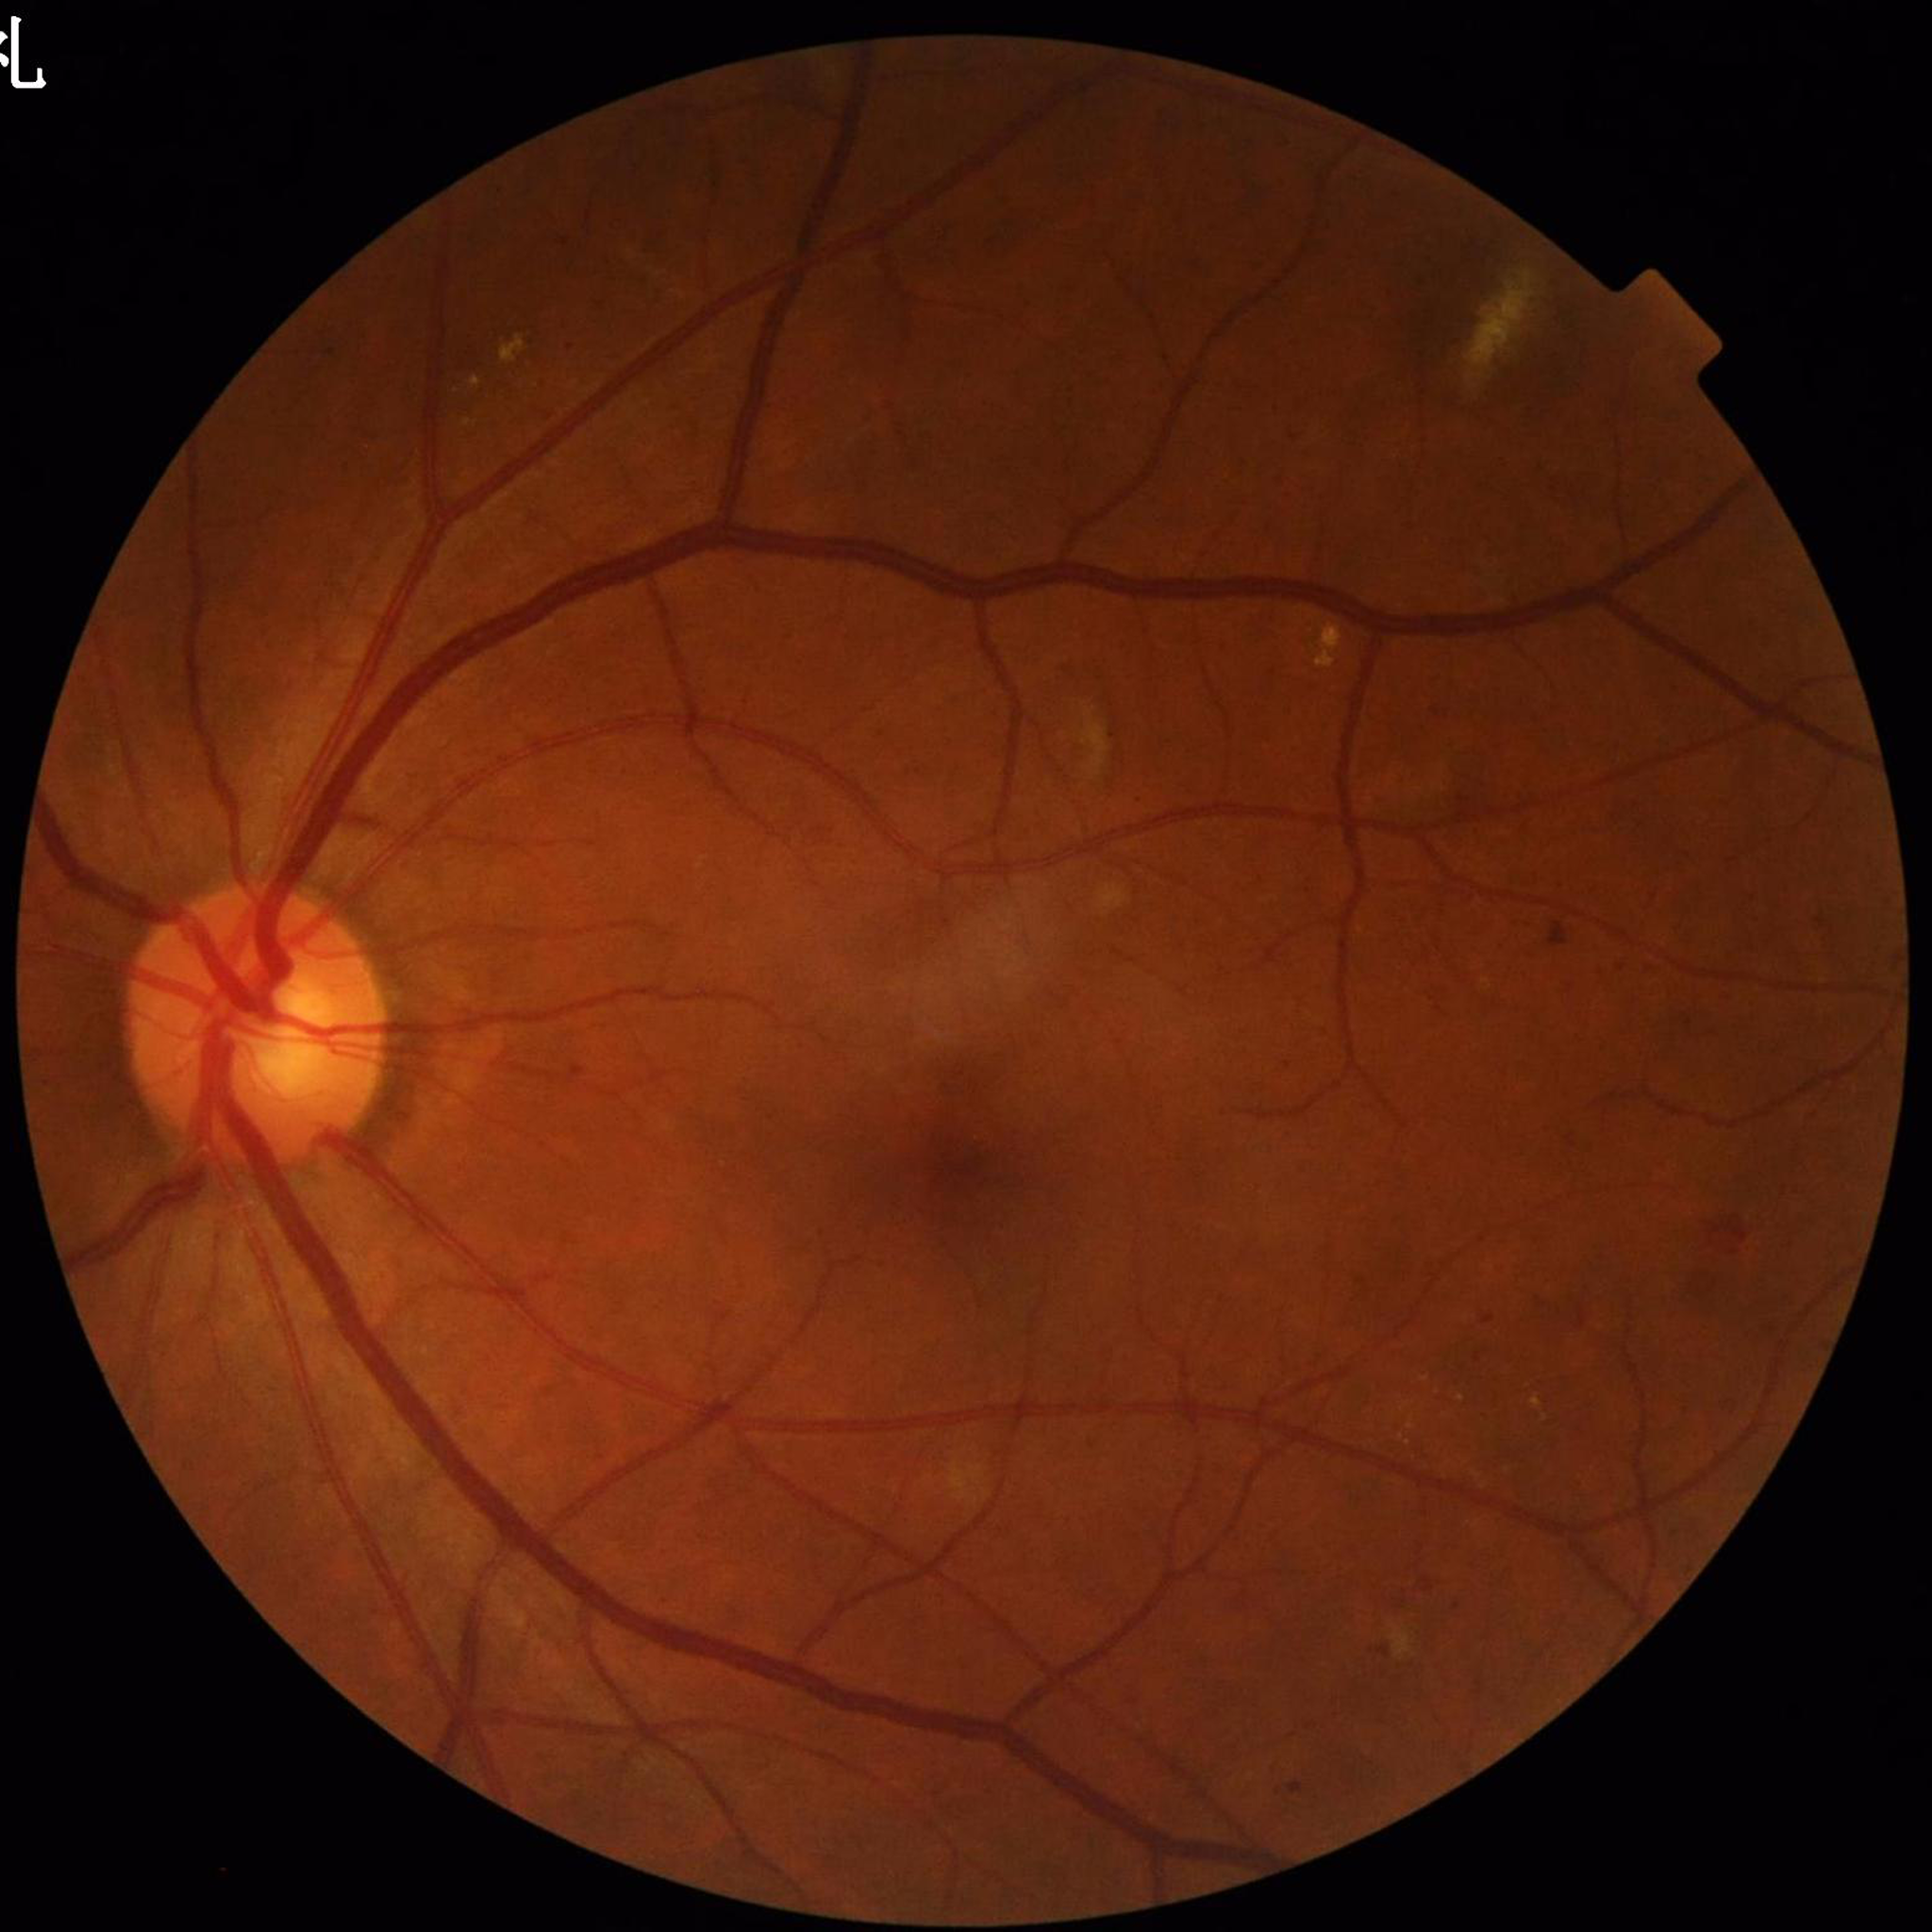

{"diagnosis": "DR"}